Fundus photo: 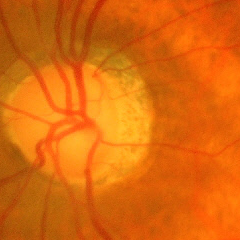 Q: Is glaucoma present?
A: Yes — advanced glaucoma.